1240x1240px; camera: Phoenix ICON (100° FOV); wide-field fundus image from infant ROP screening.
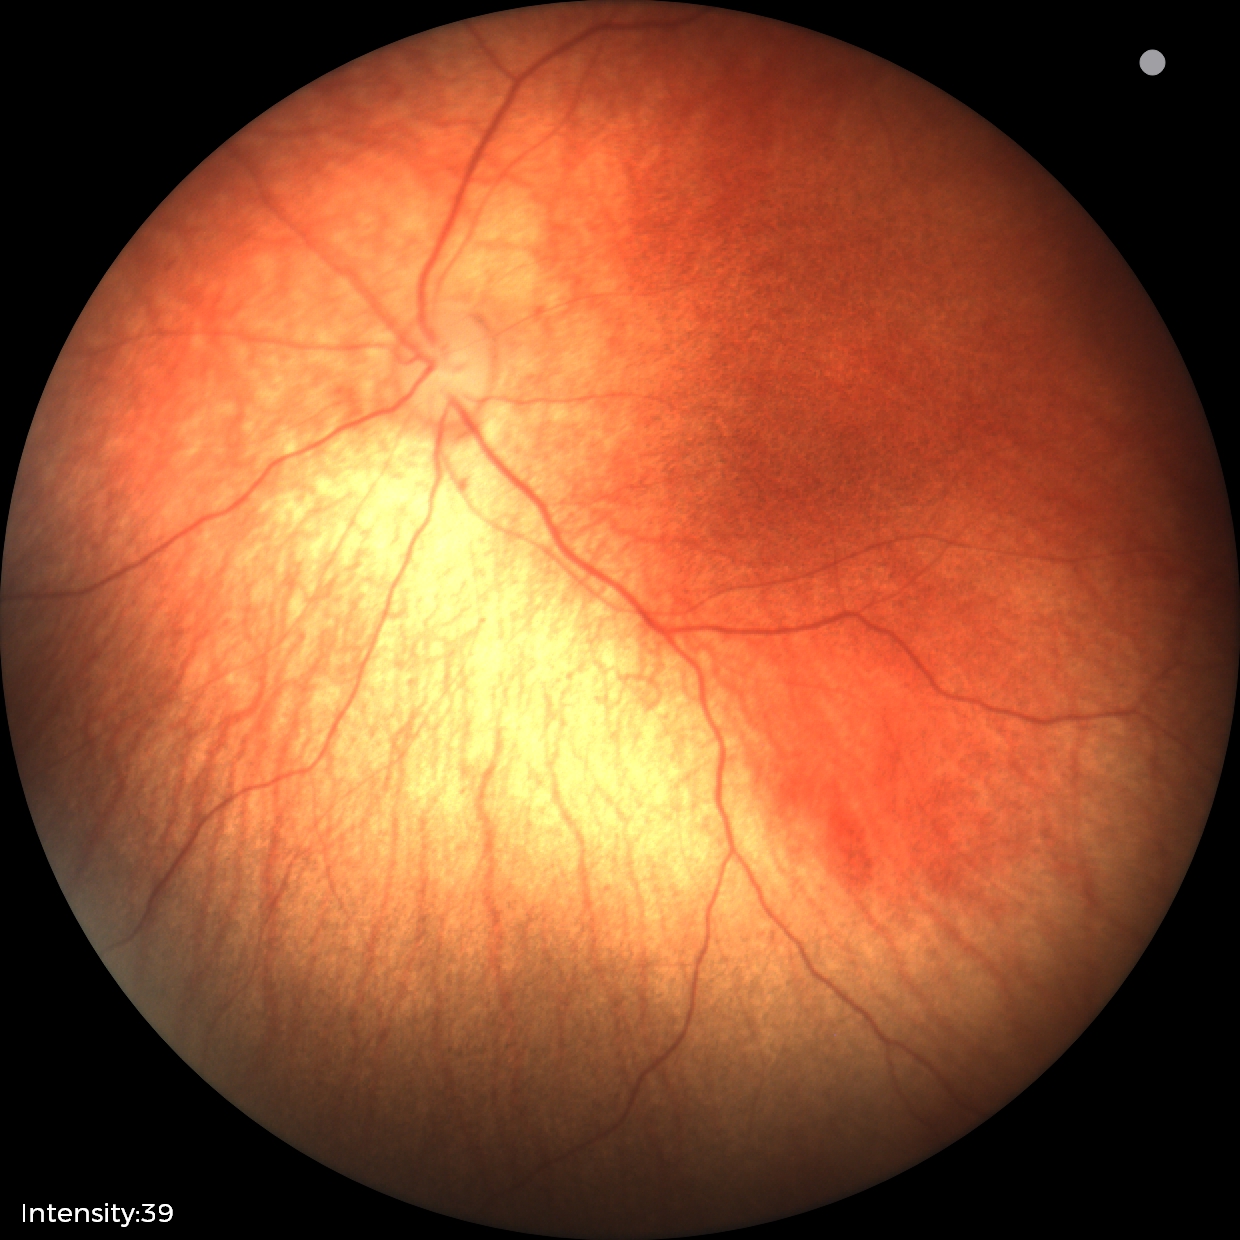

No retinal pathology identified on screening.